CFP: 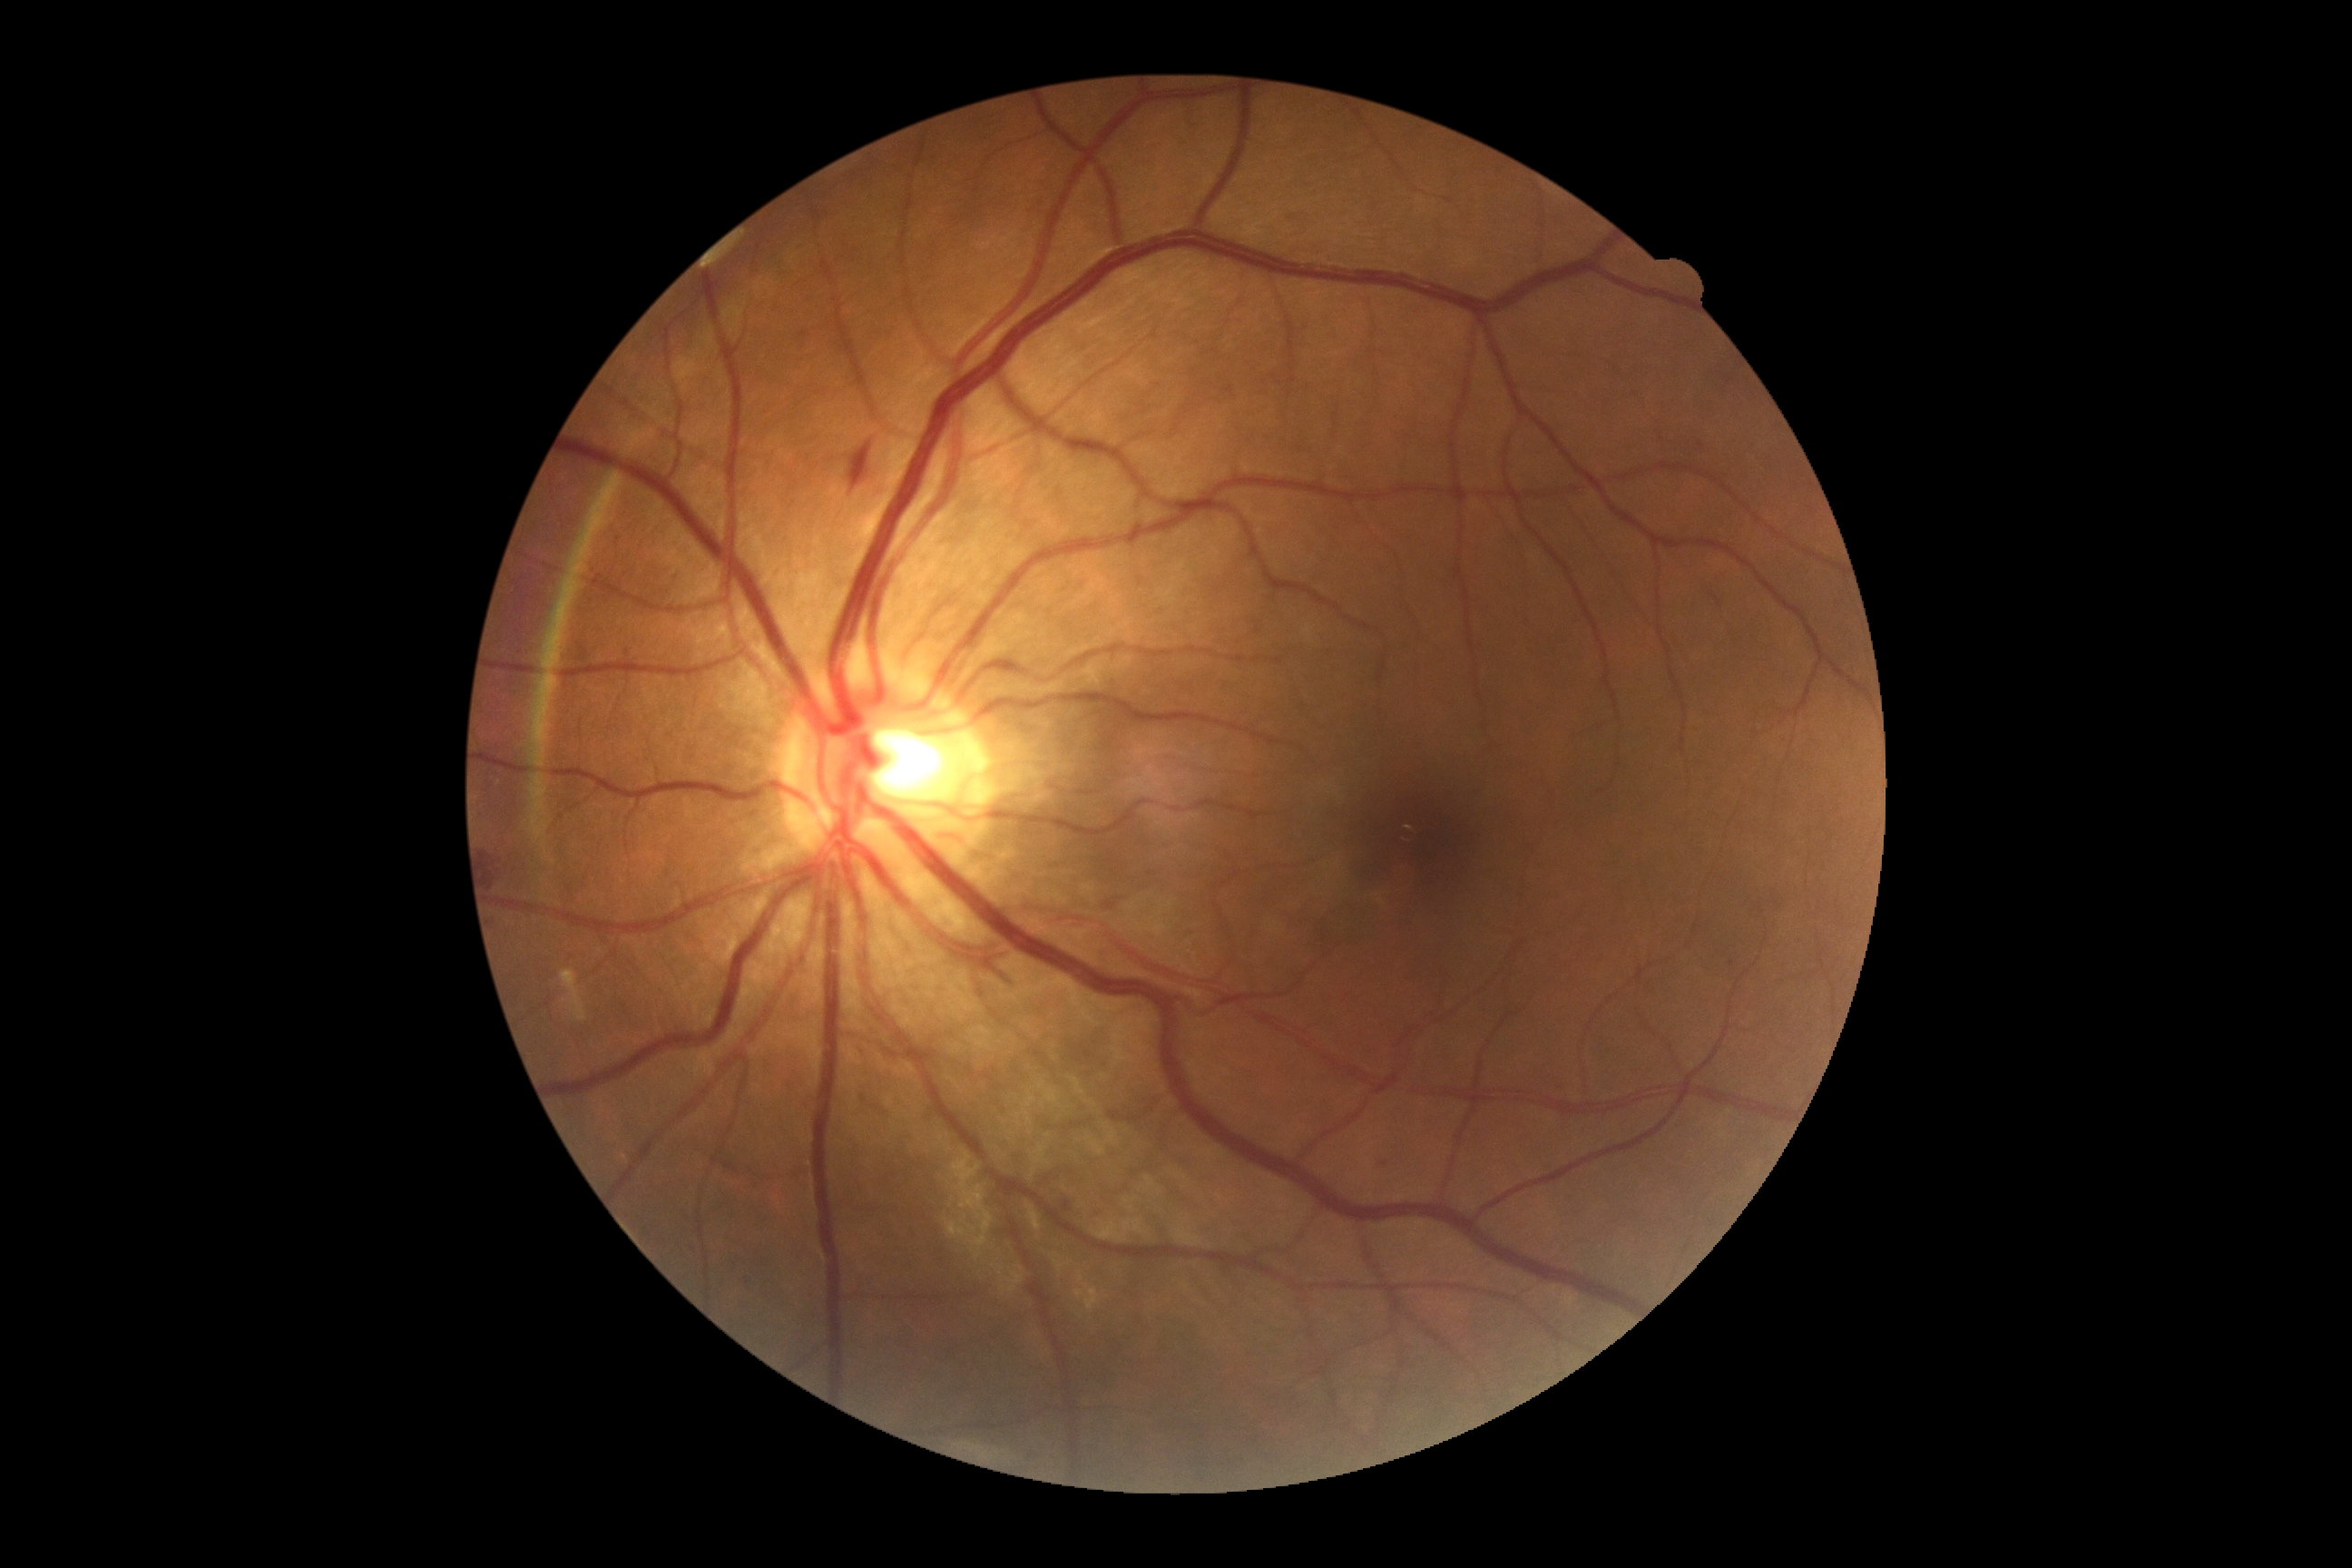

DR is 2/4.